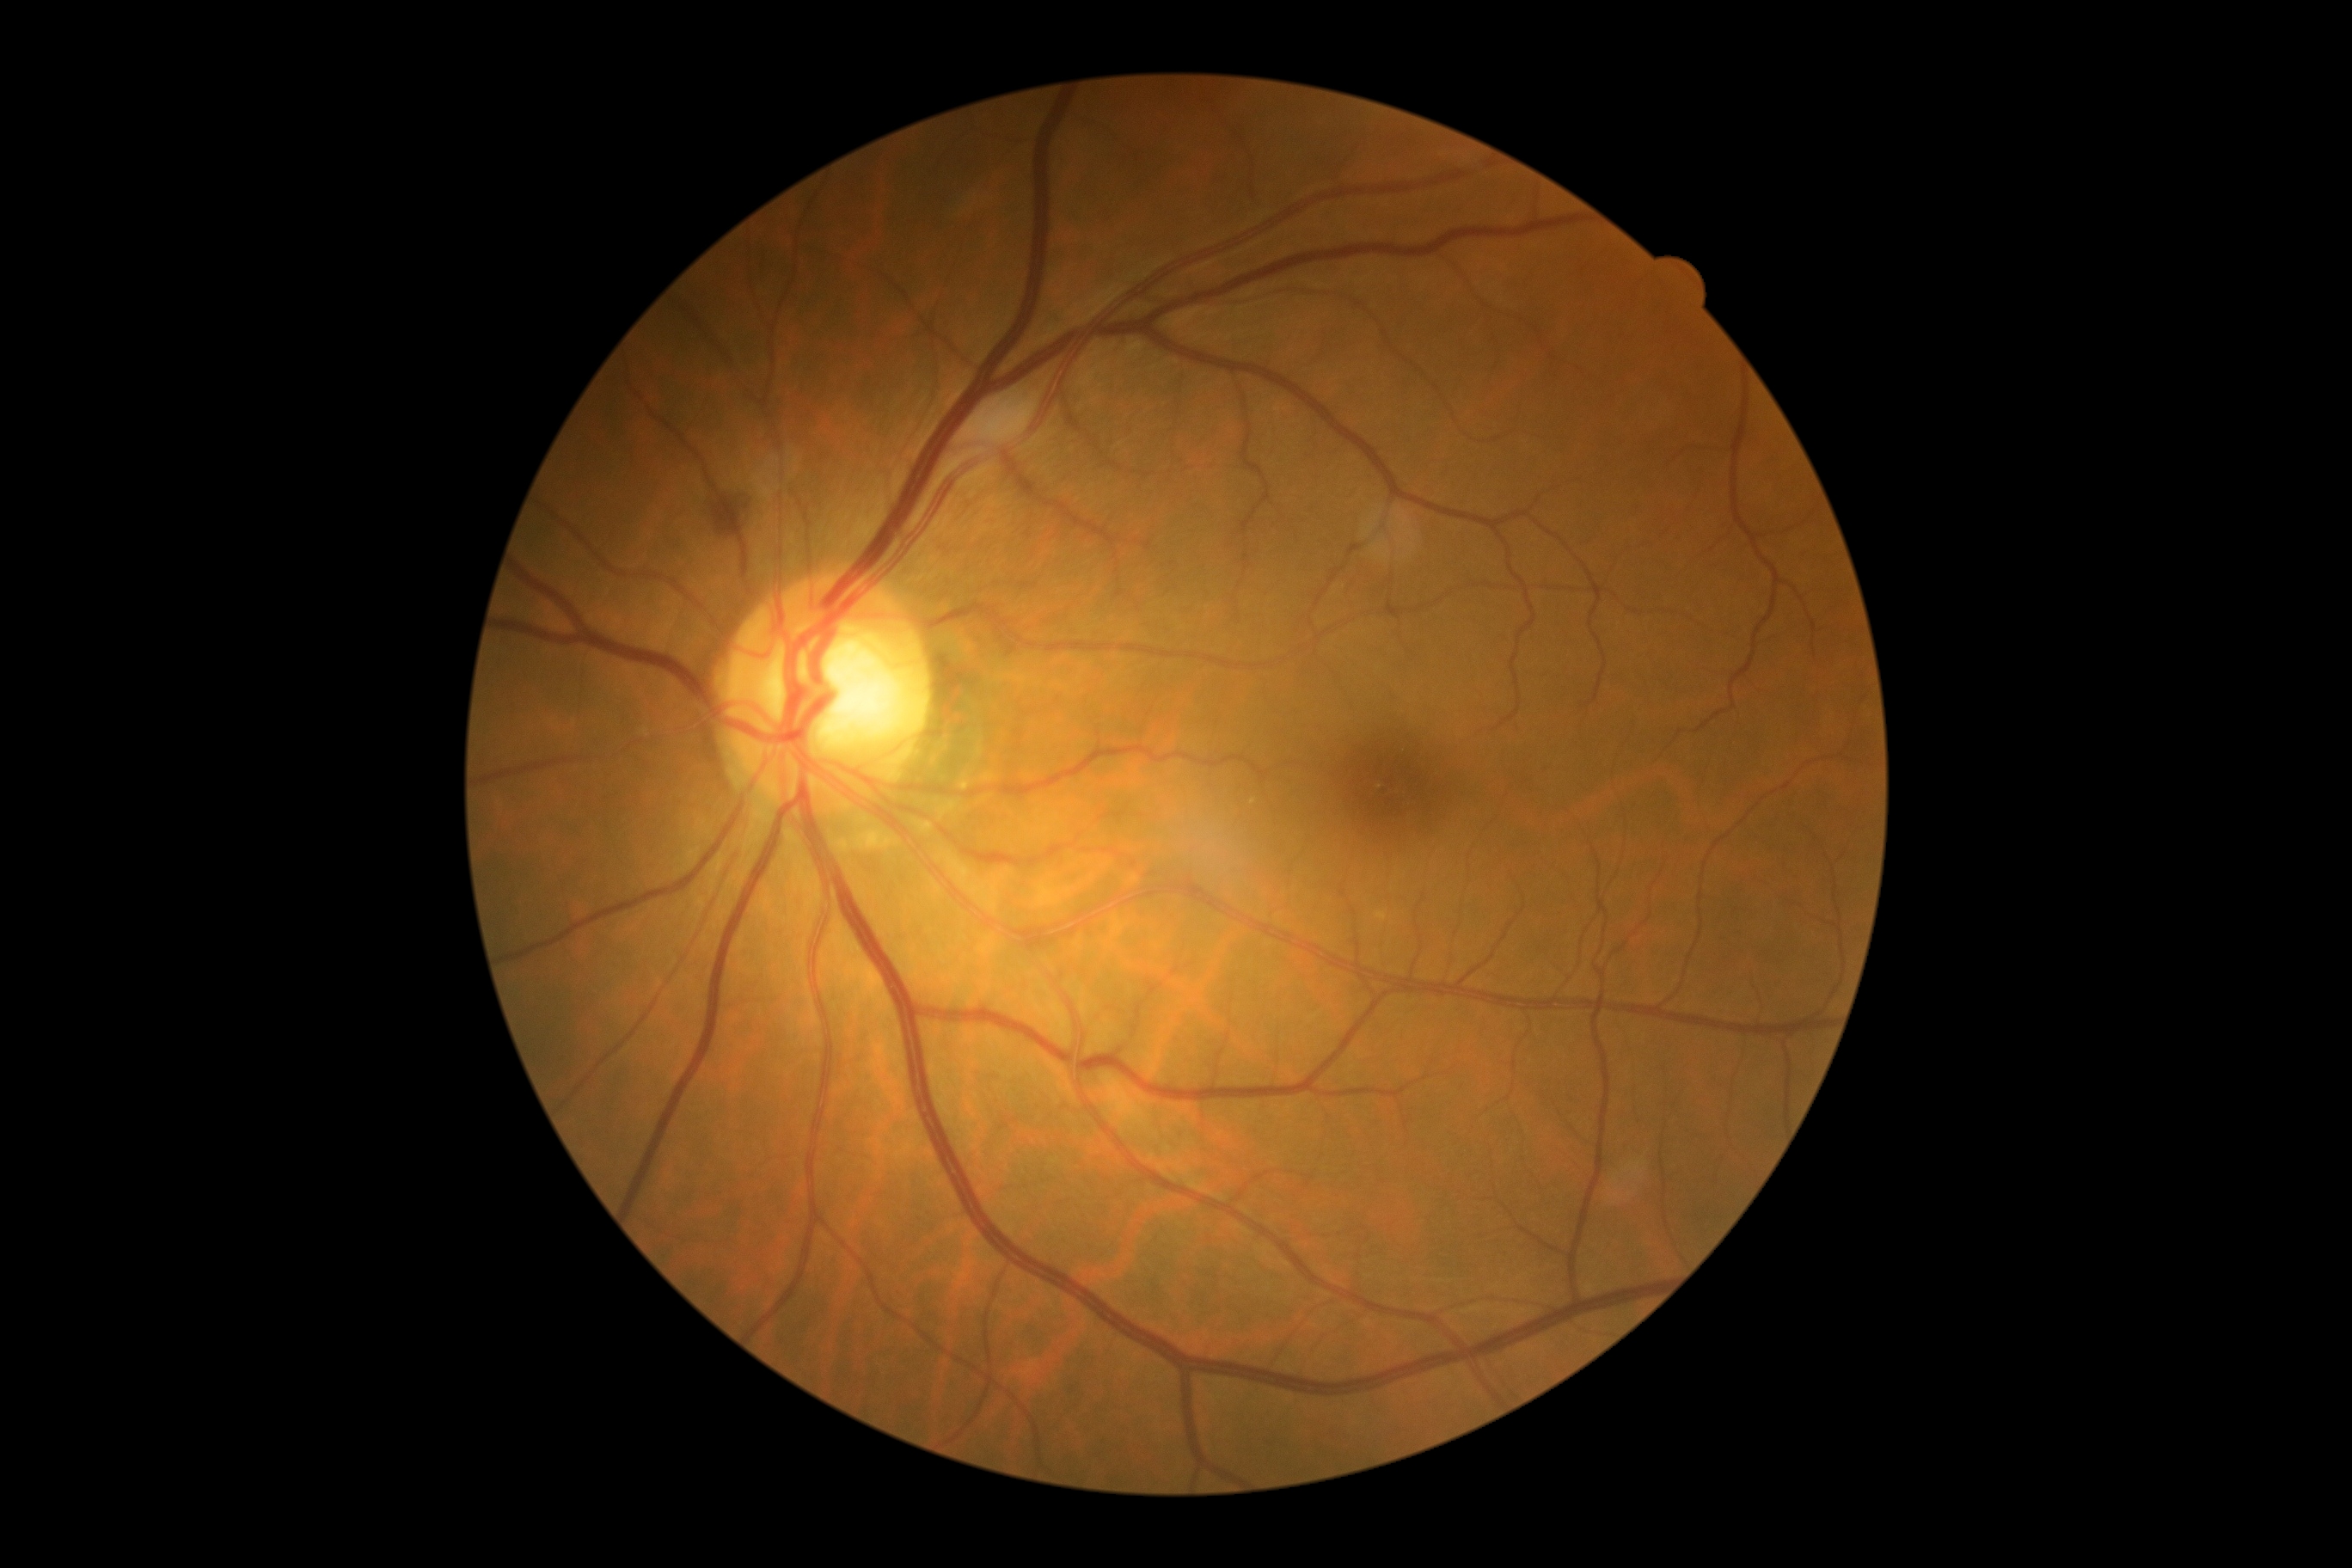

No signs of diabetic retinopathy. DR grade: no apparent retinopathy (0) — no visible signs of diabetic retinopathy.